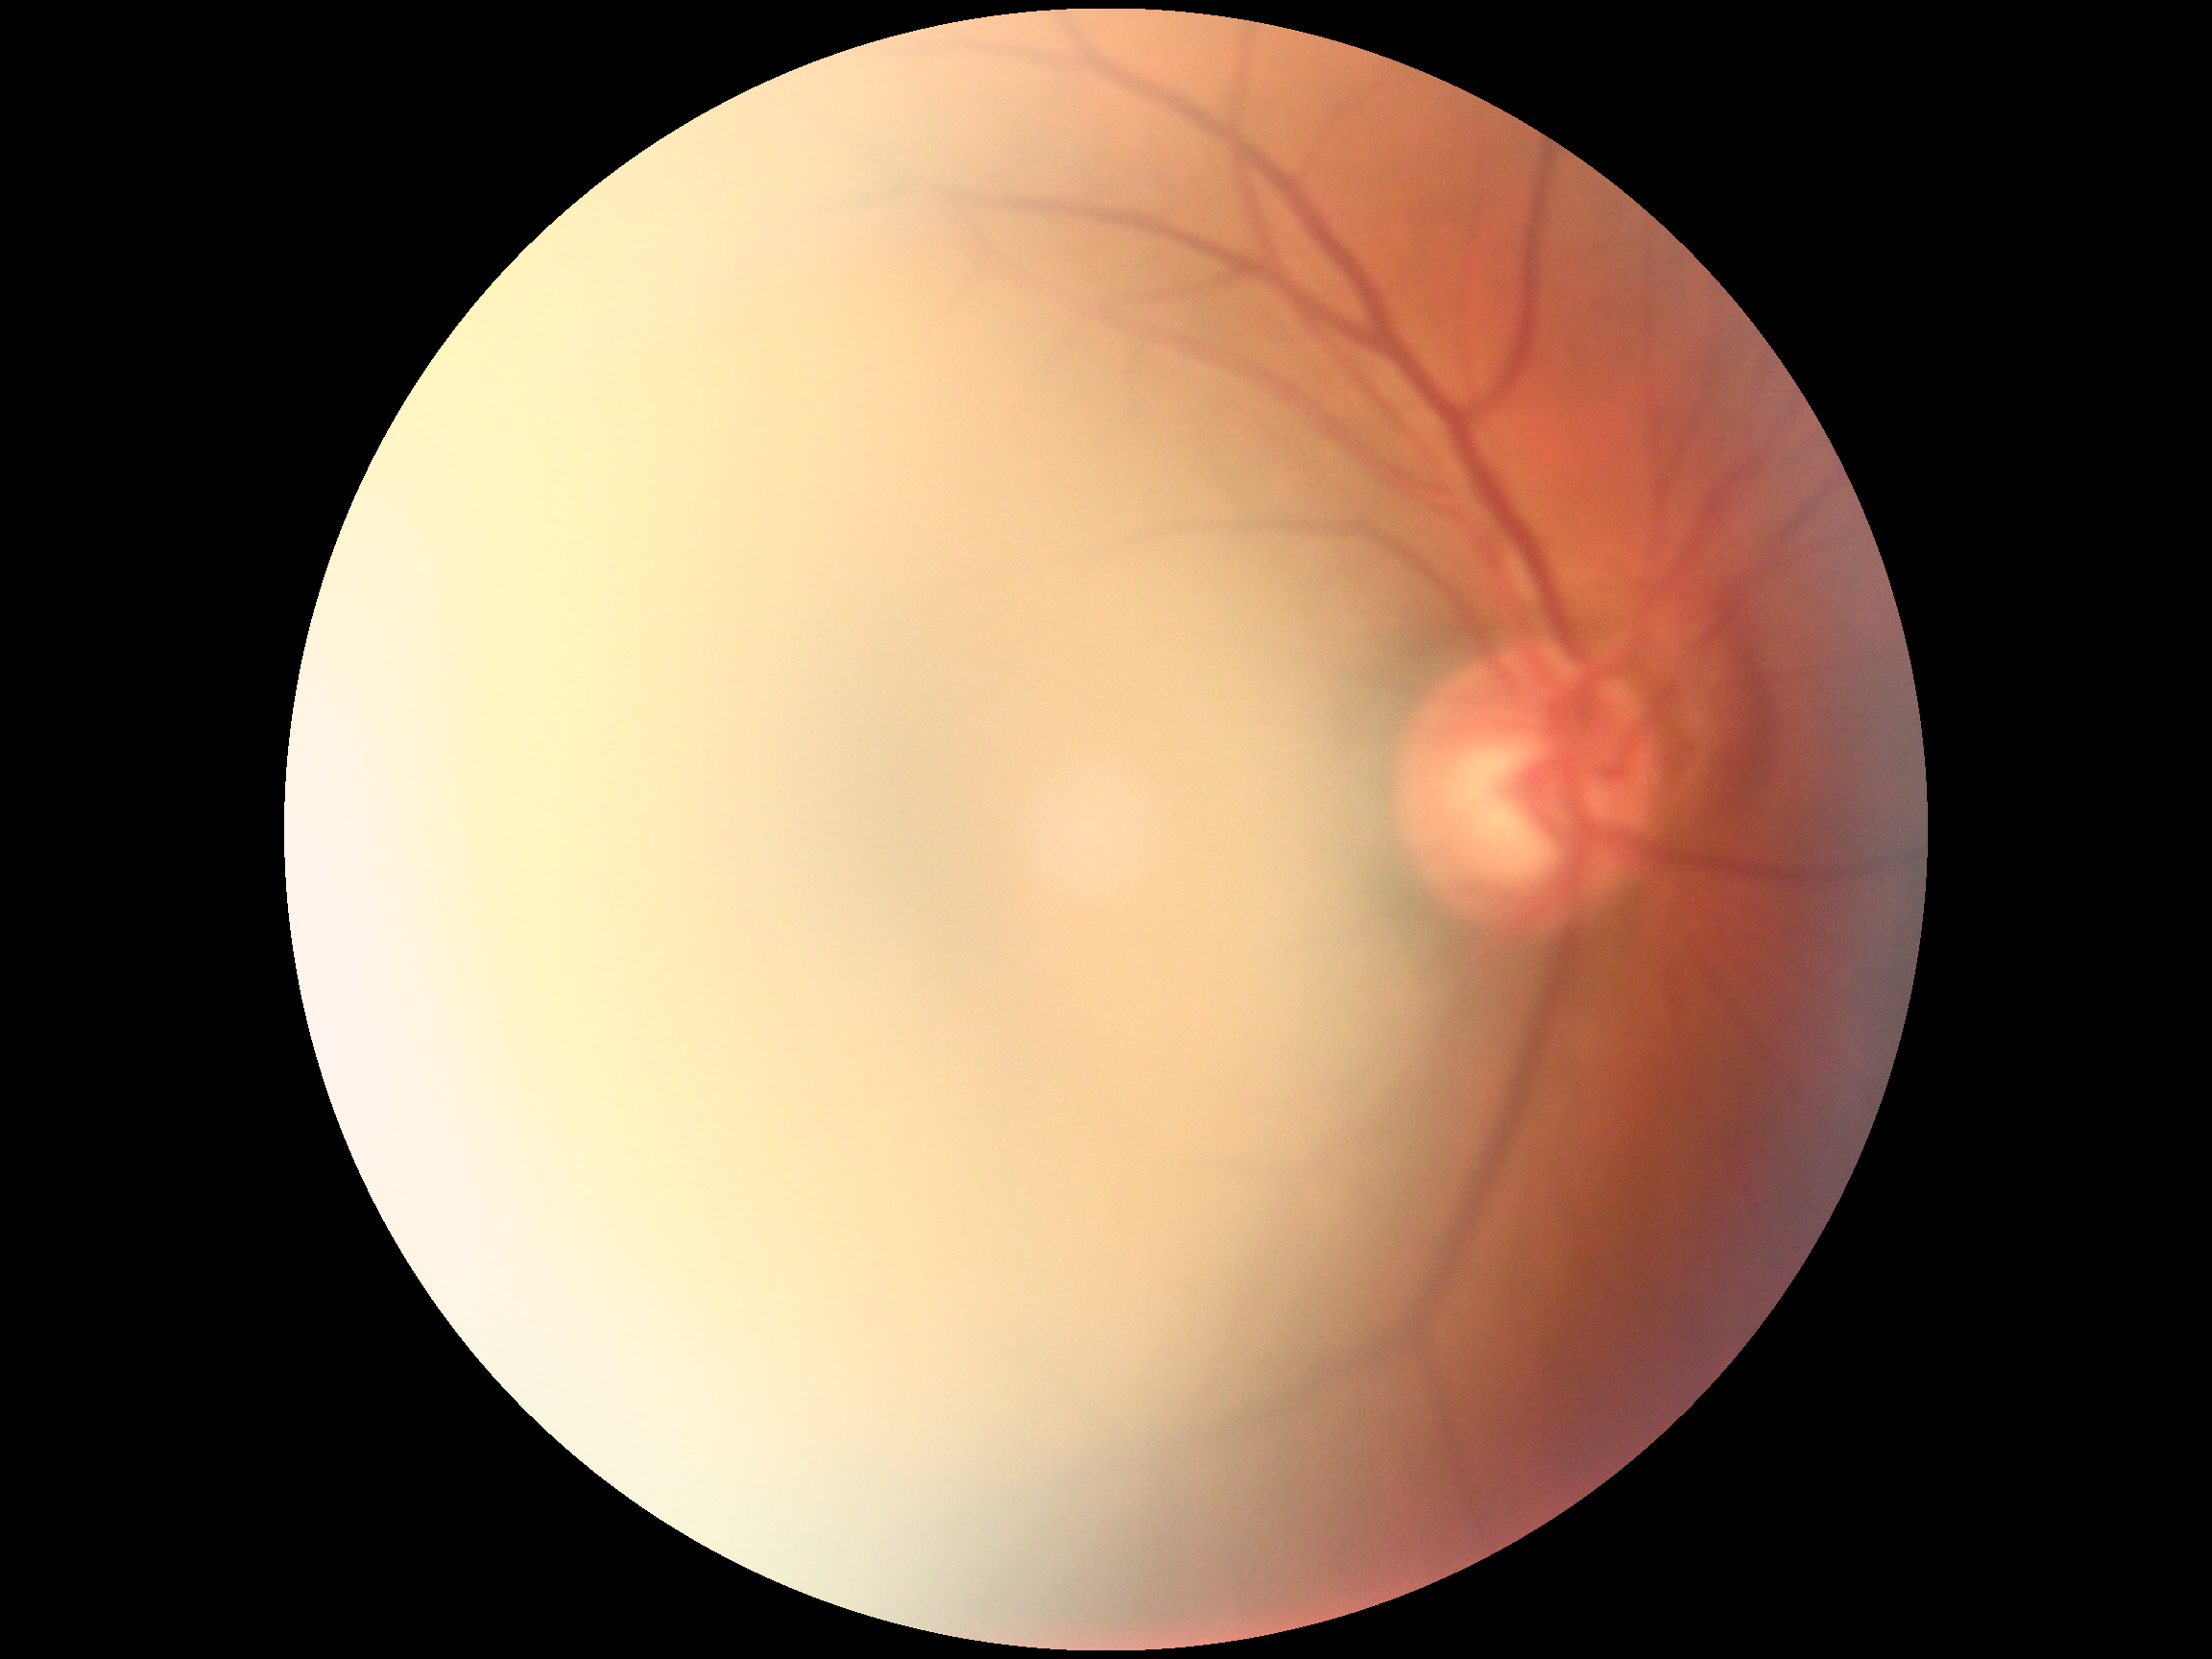 DR severity: ungradable due to poor image quality
image quality: too poor for DR grading